FOV: 45 degrees.
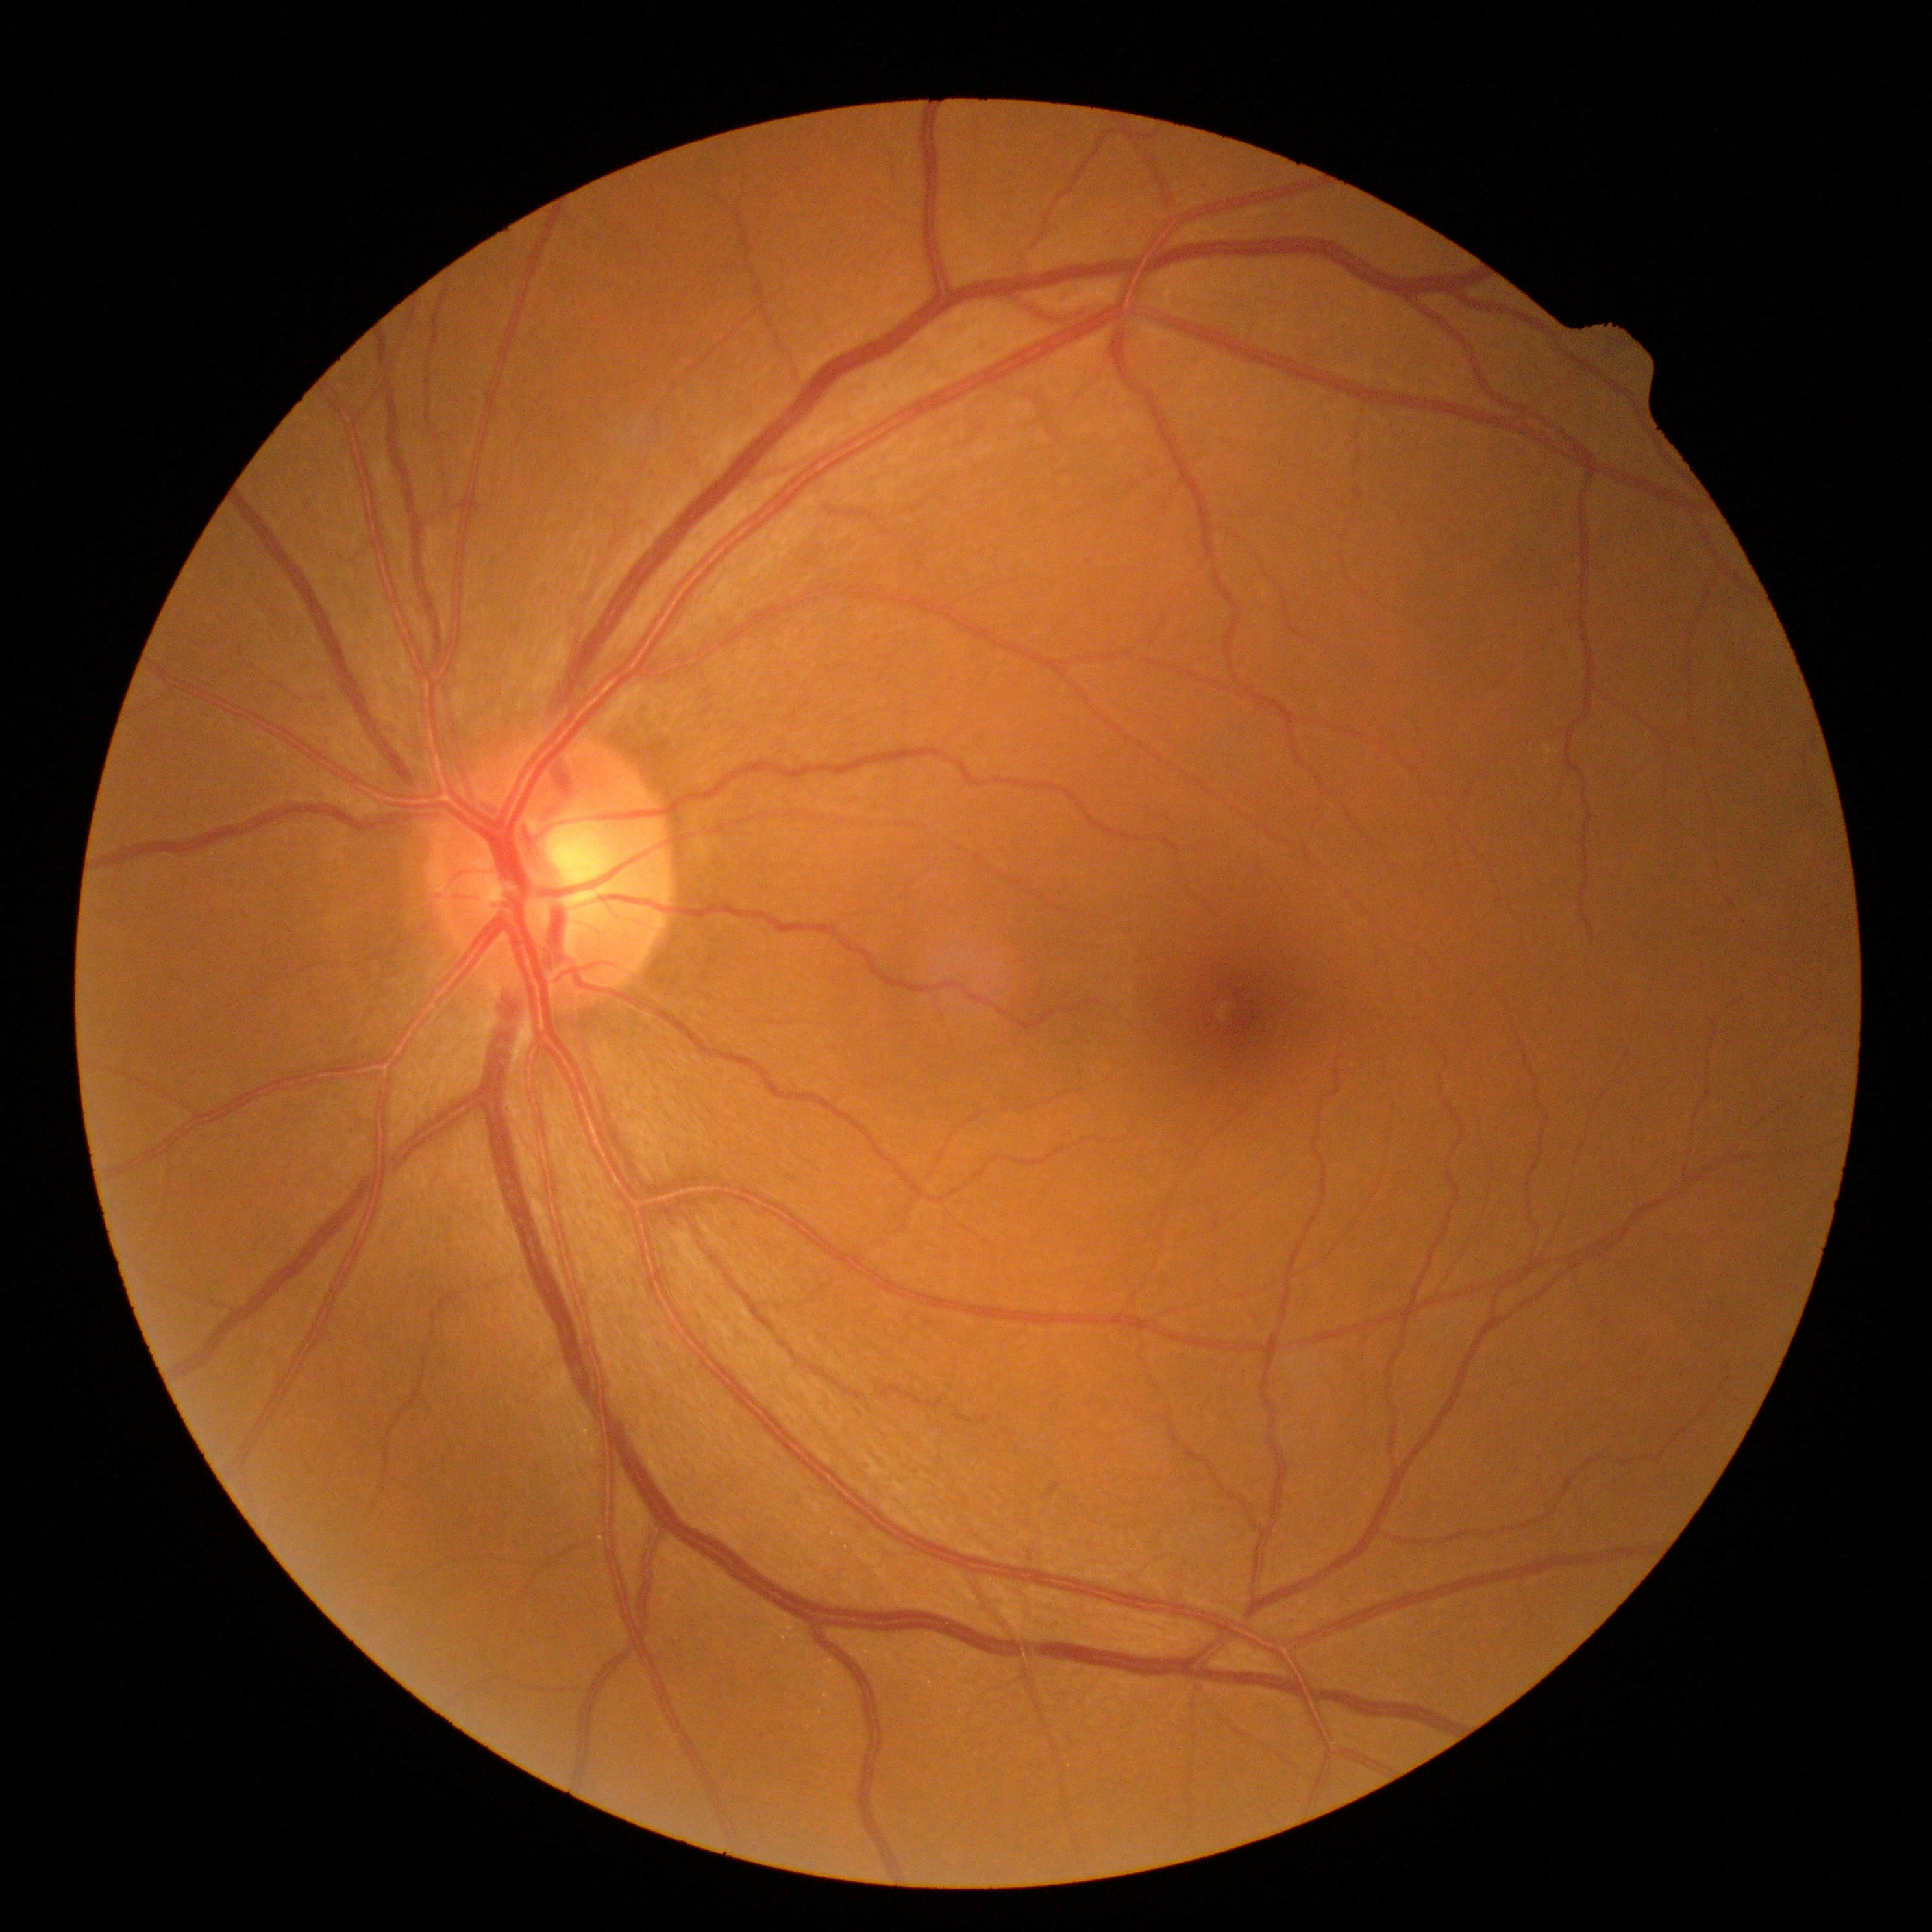 diabetic retinopathy grade=0/4; DR impression=no apparent DR.